Wide-field fundus photograph from neonatal ROP screening — 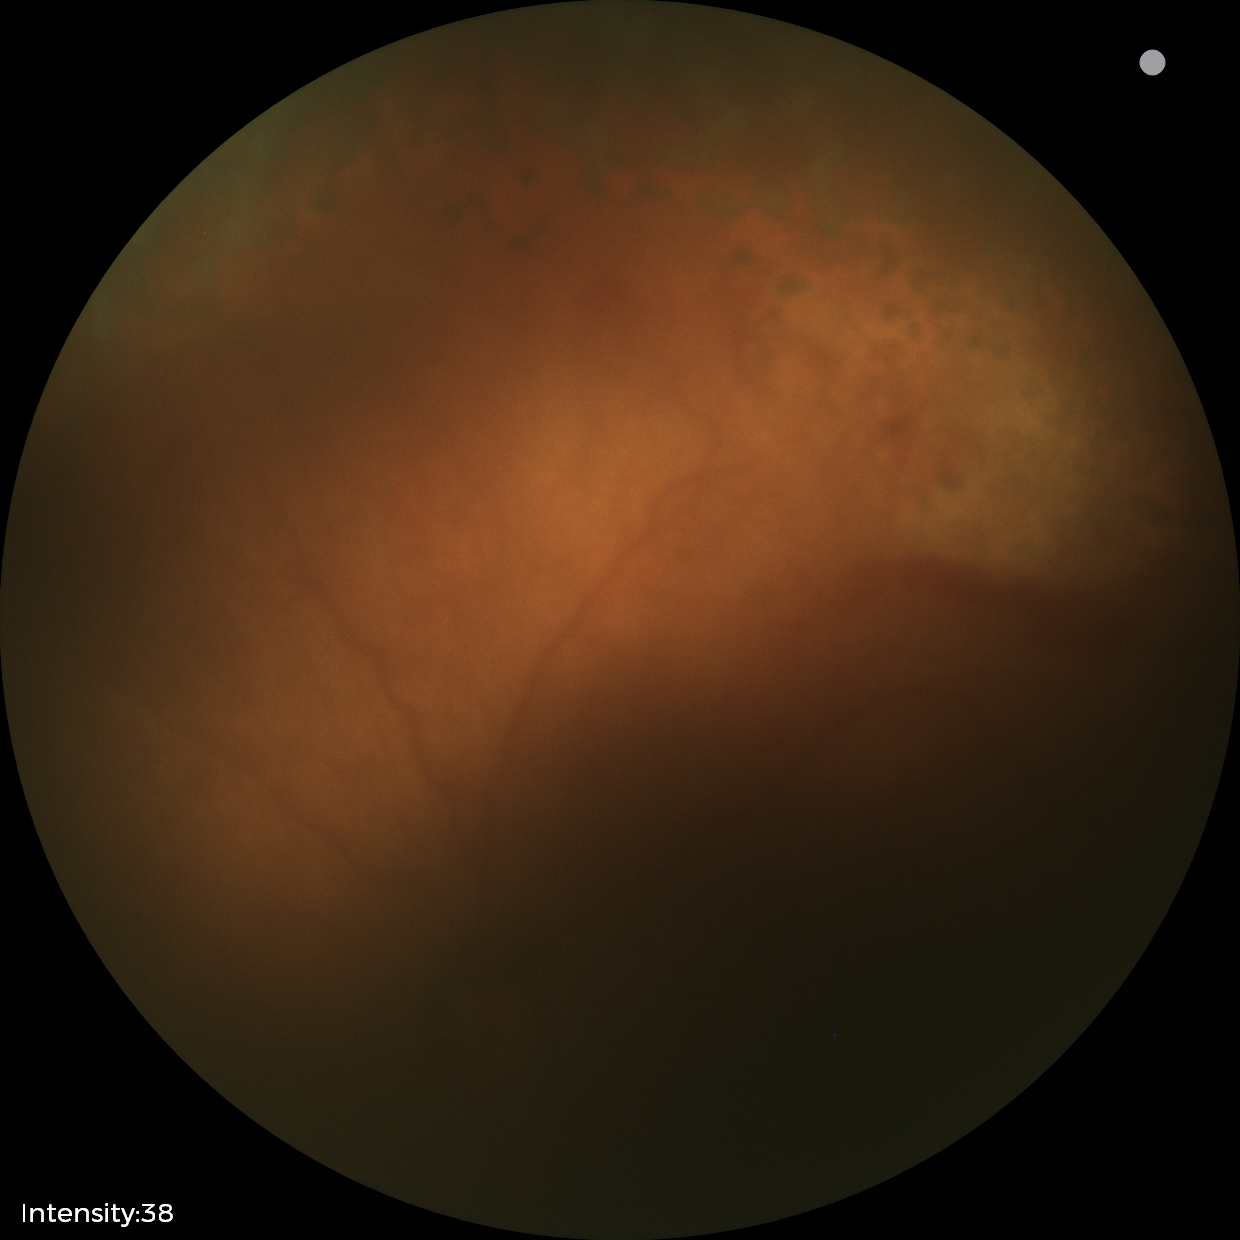 Screening diagnosis: status post retinopathy of prematurity, plus disease: absent.